CFP.
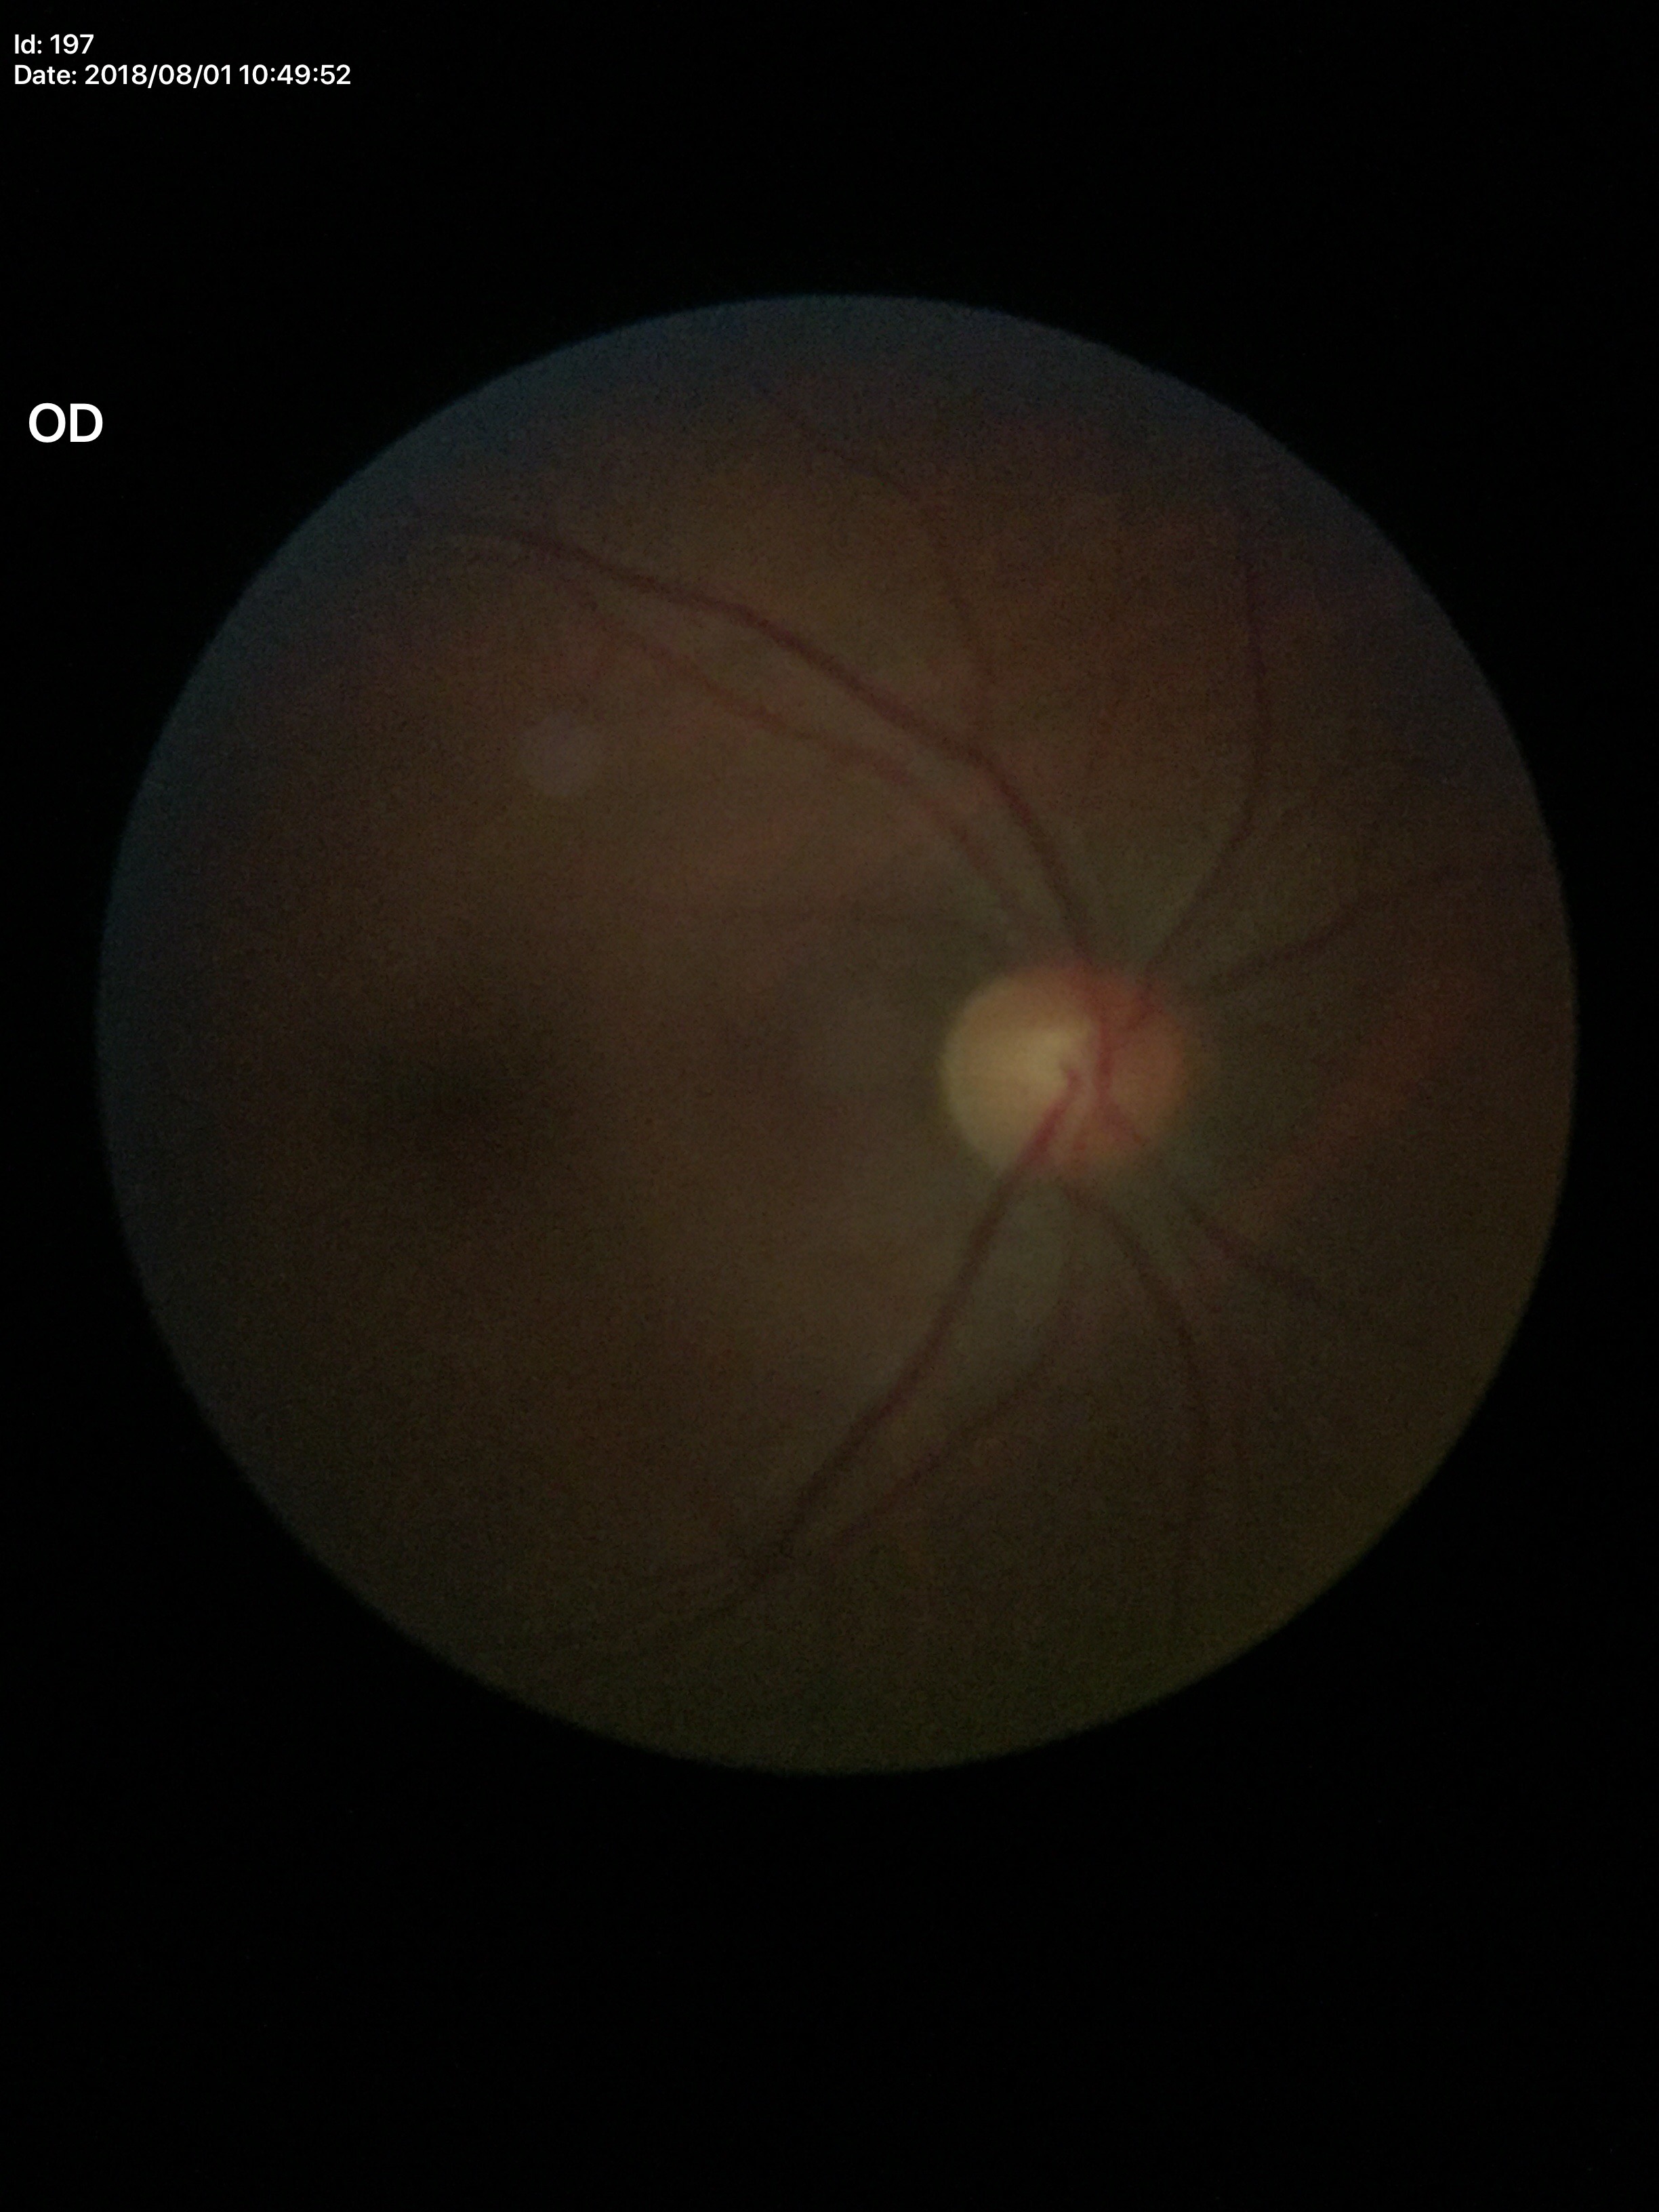 {"glaucoma_decision": "no suspicious findings", "vcdr": "0.50"}